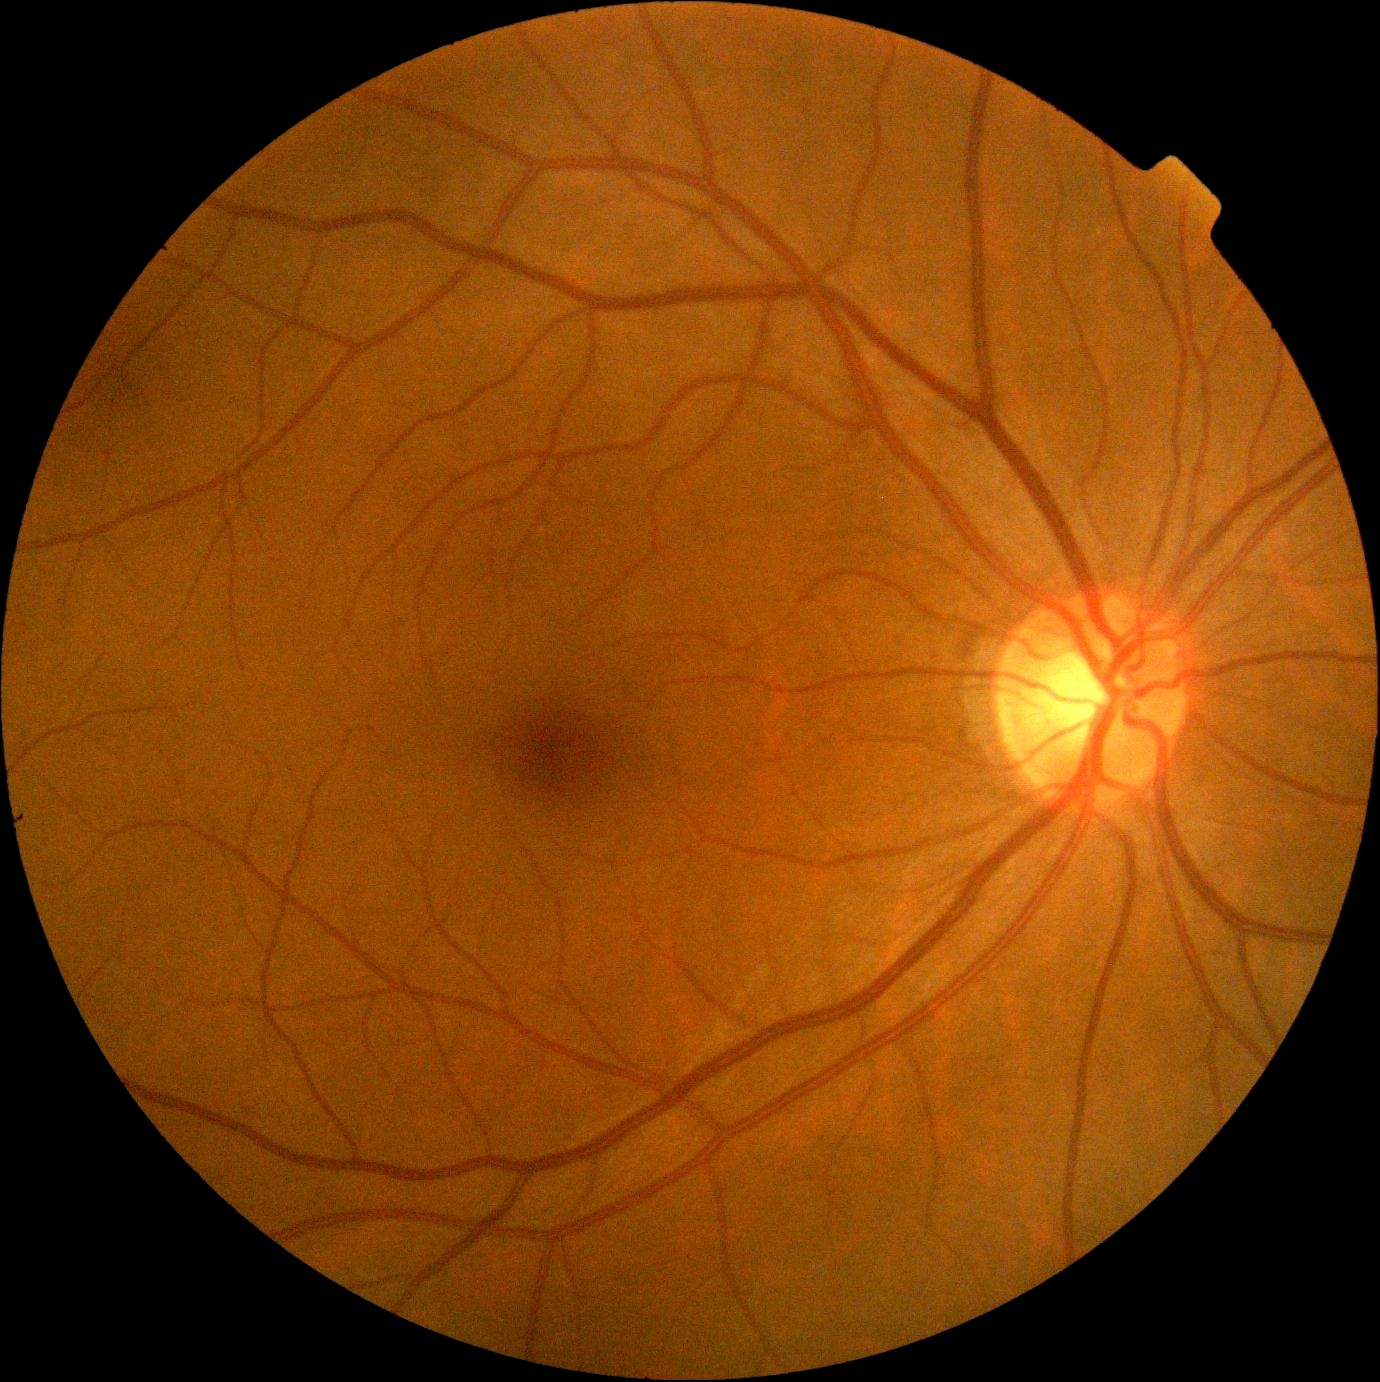
{"dr_grade": "no apparent retinopathy (0)"}